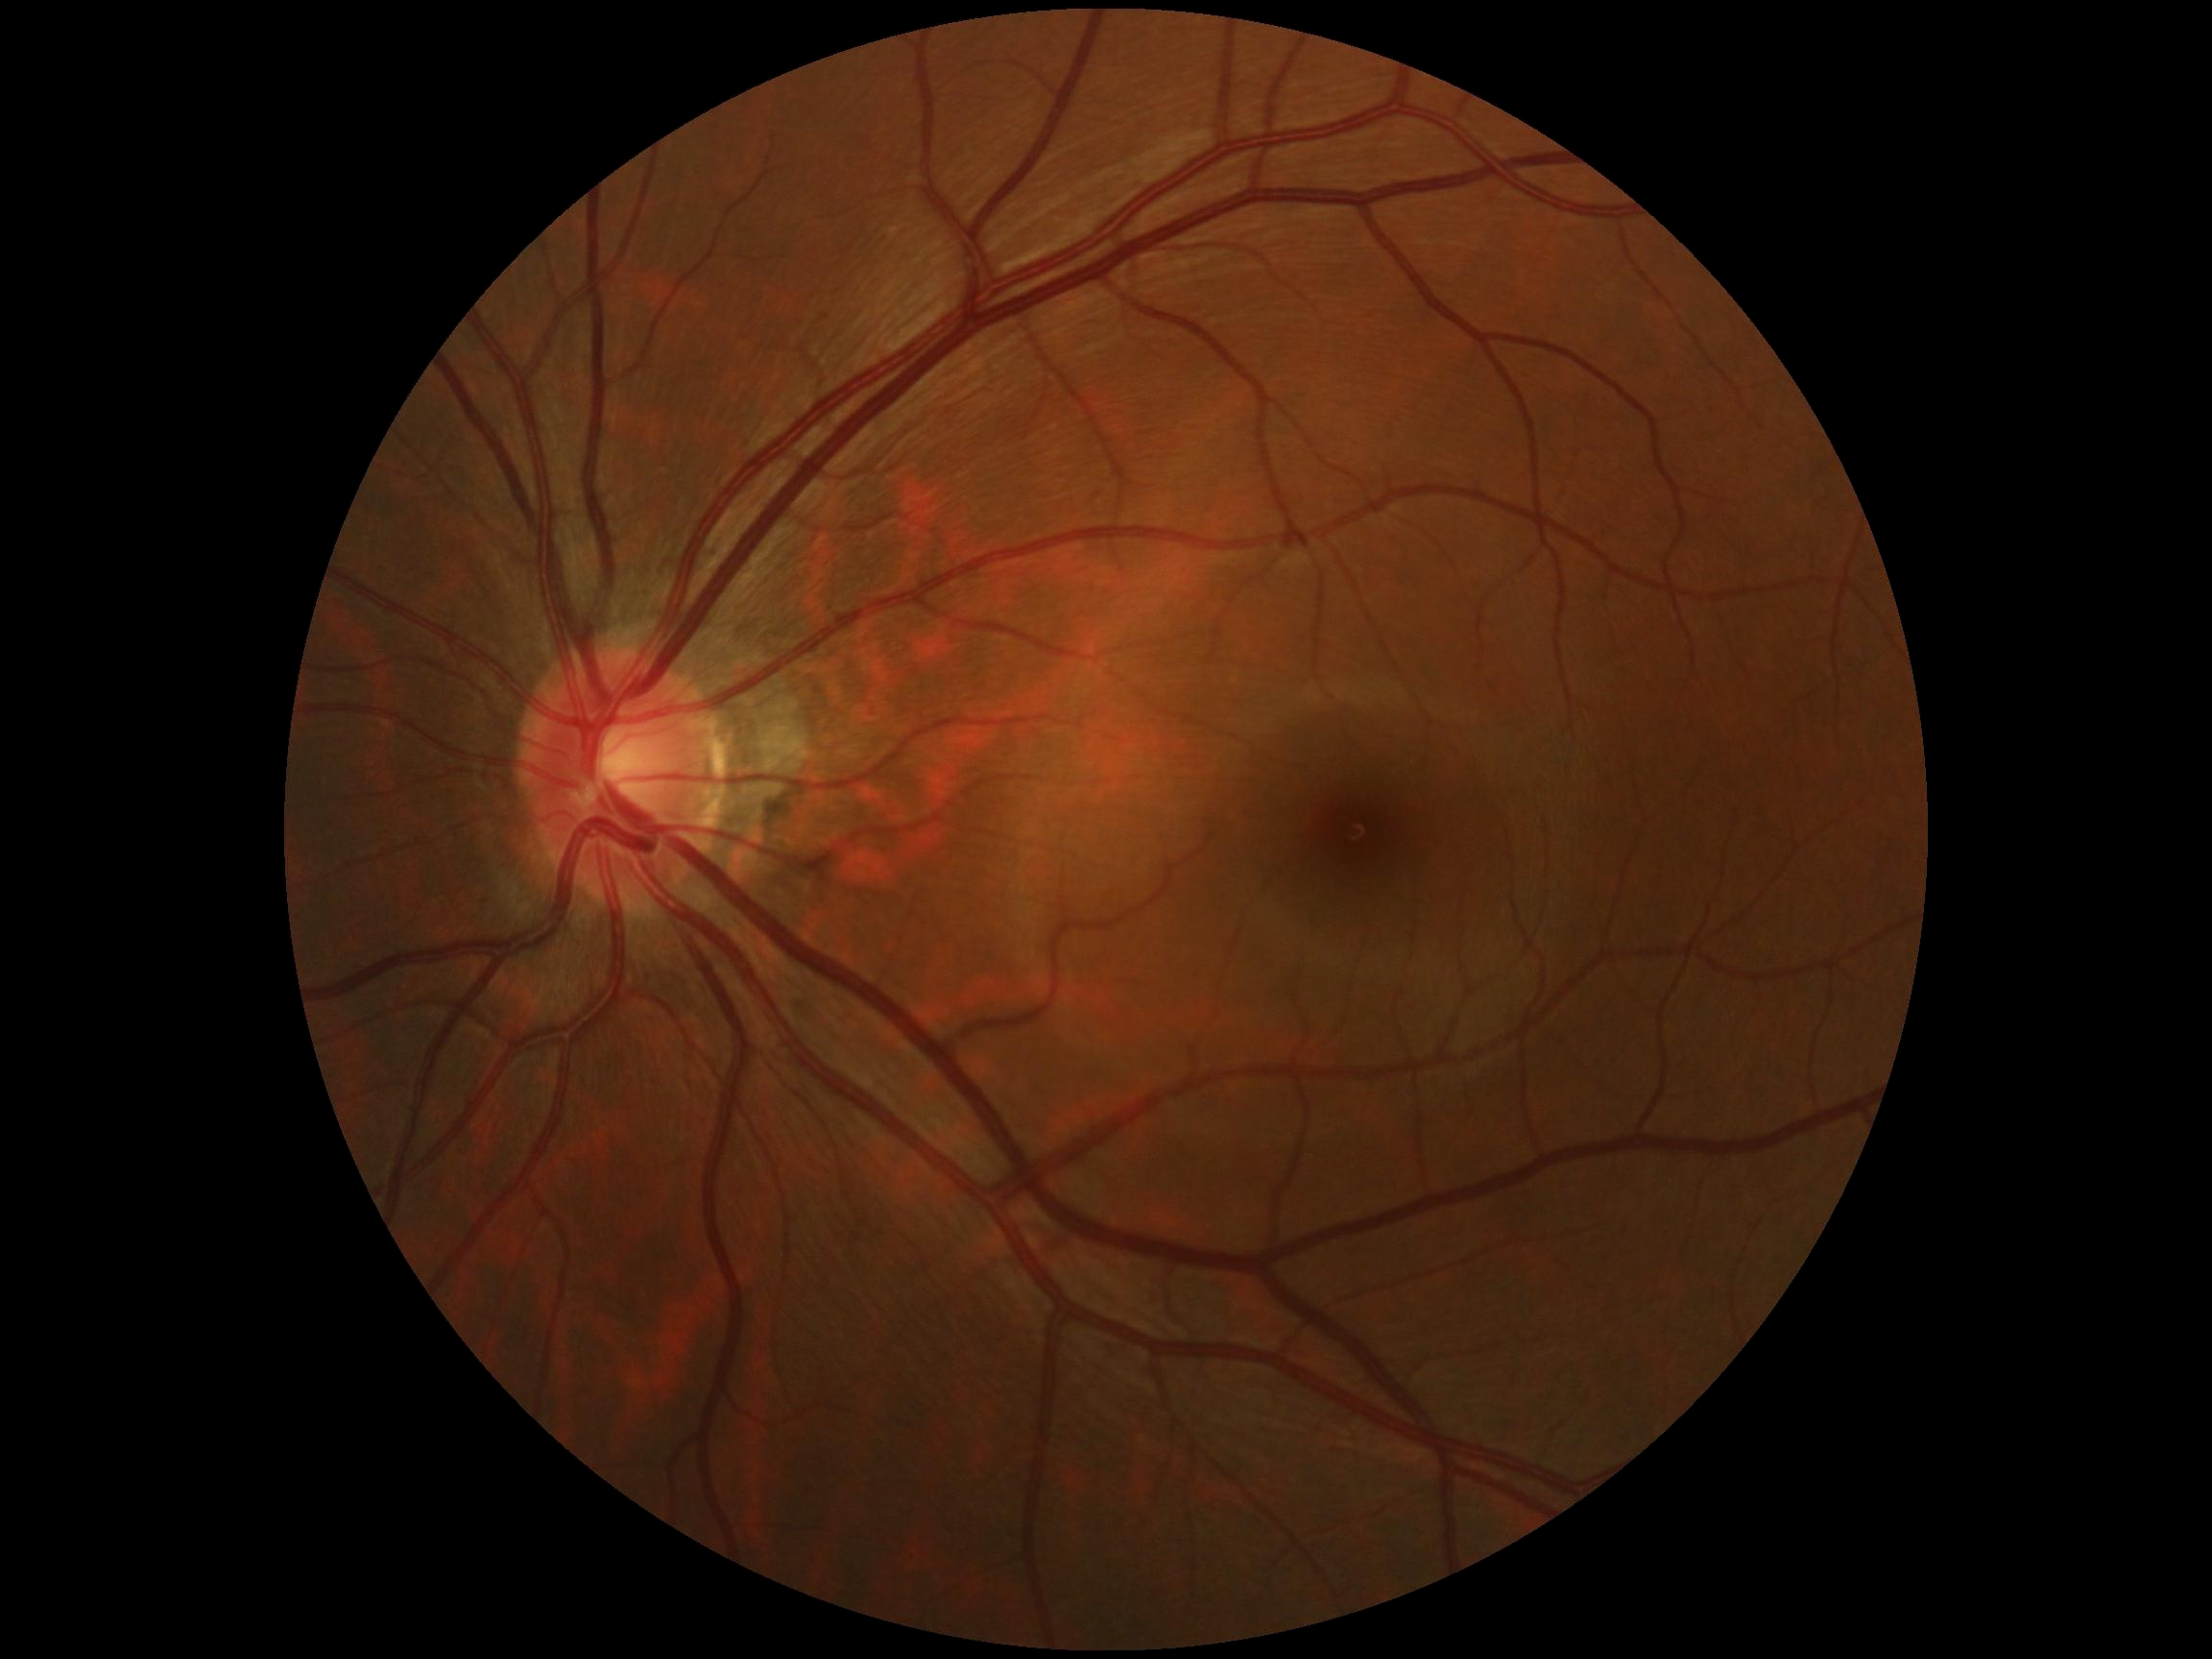 DR grade = 0
DR impression = no DR findings